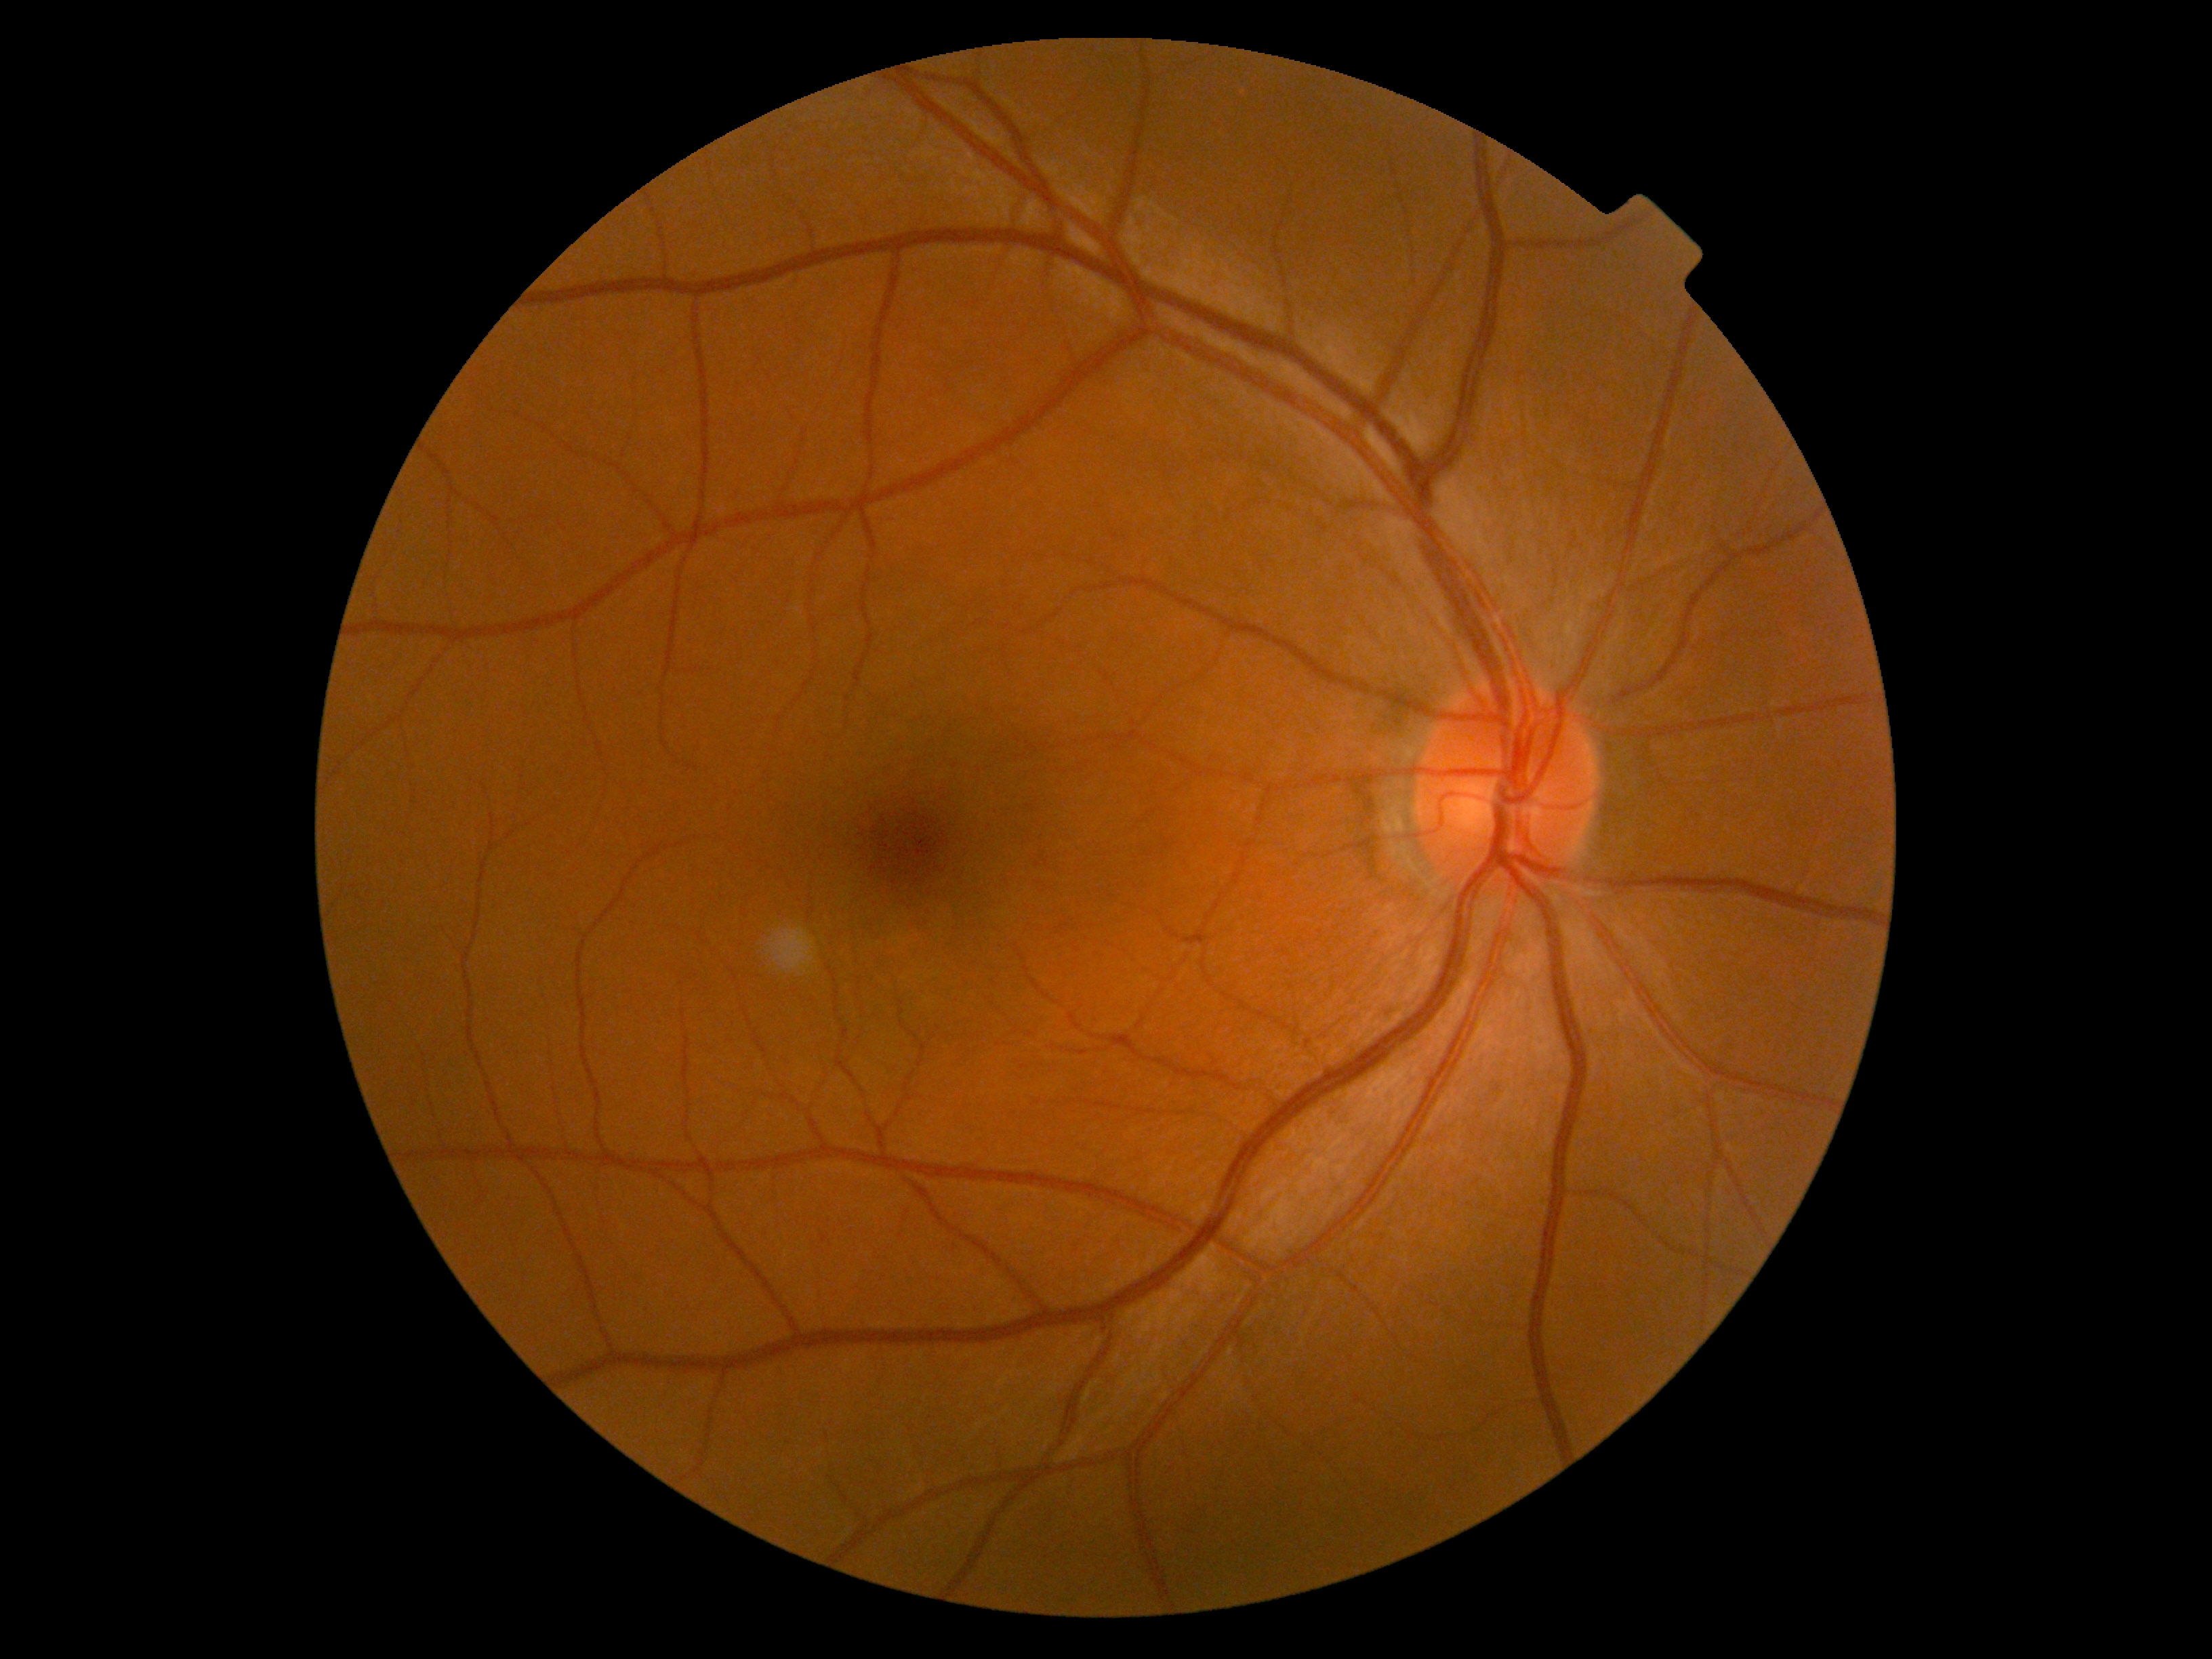
Diabetic retinopathy severity is grade 0 (no apparent retinopathy).